CFP; acquired with a Remidio Fundus on Phone; 1659 by 2212 pixels:
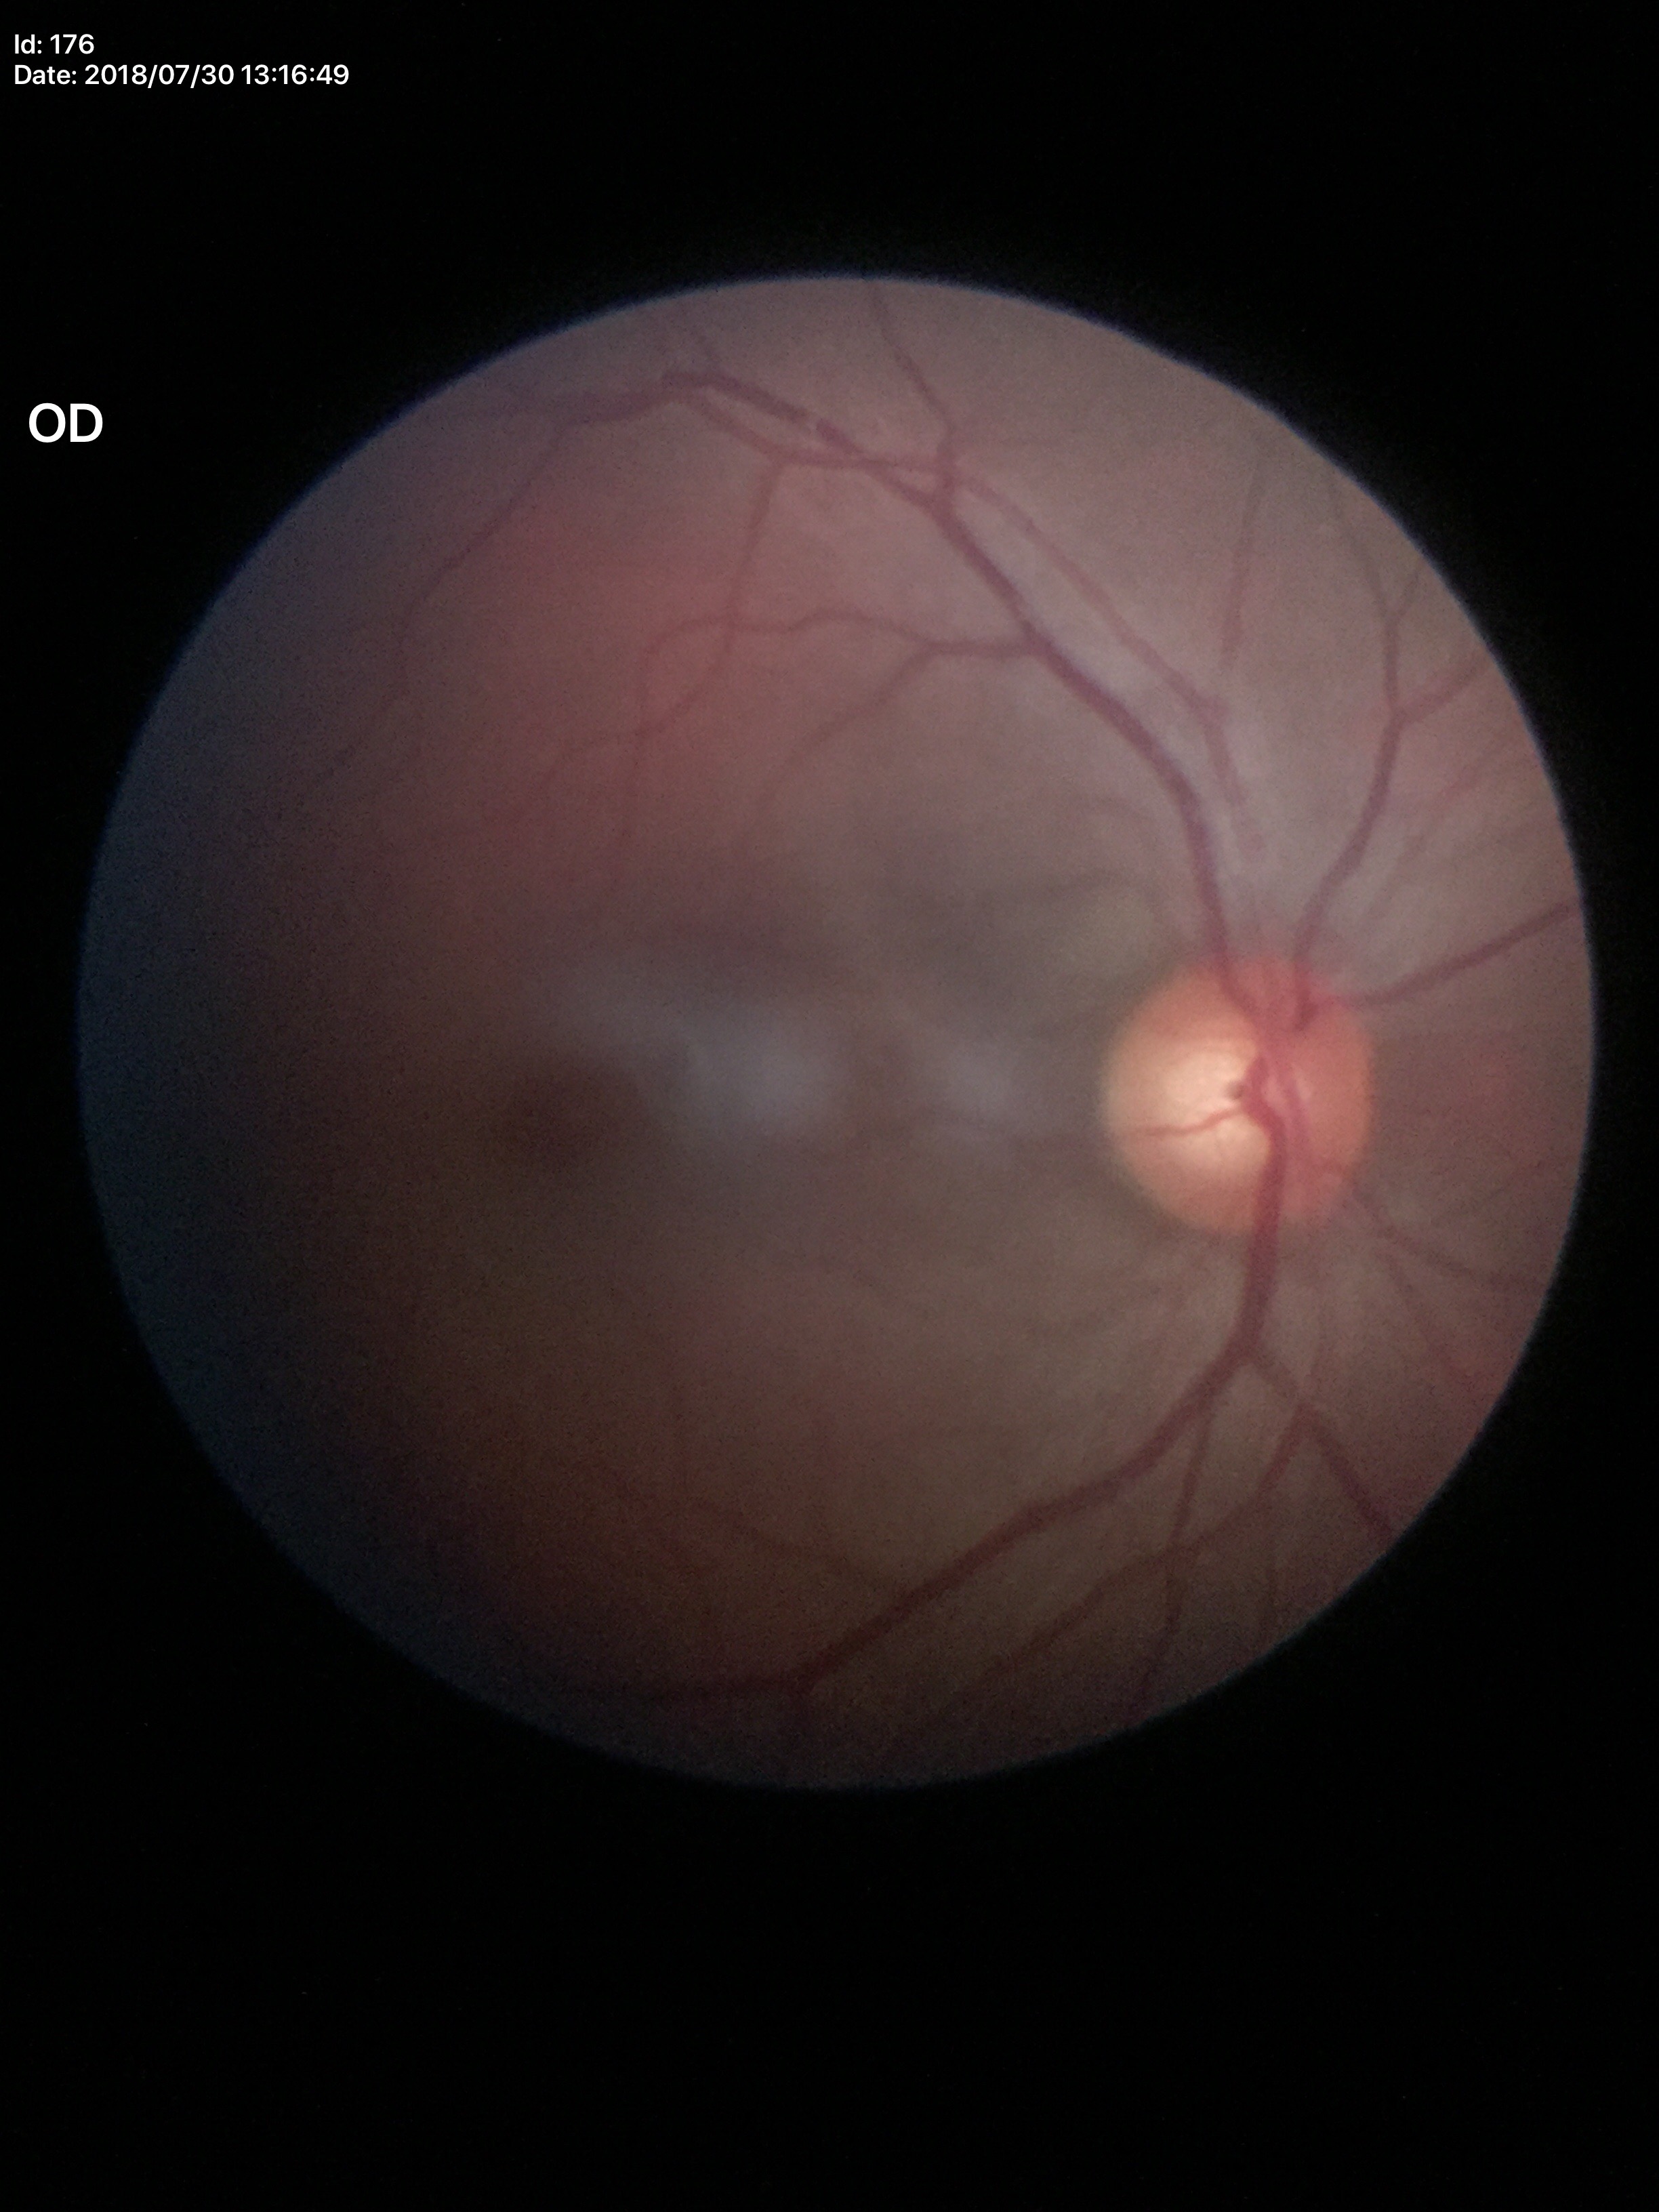 Annotations:
– VCDR · 0.61
– Glaucoma assessment · negative (2/5 graders called glaucoma suspect)
– HCDR · 0.56
– ACDR · 0.34